45° field of view; 848x848.
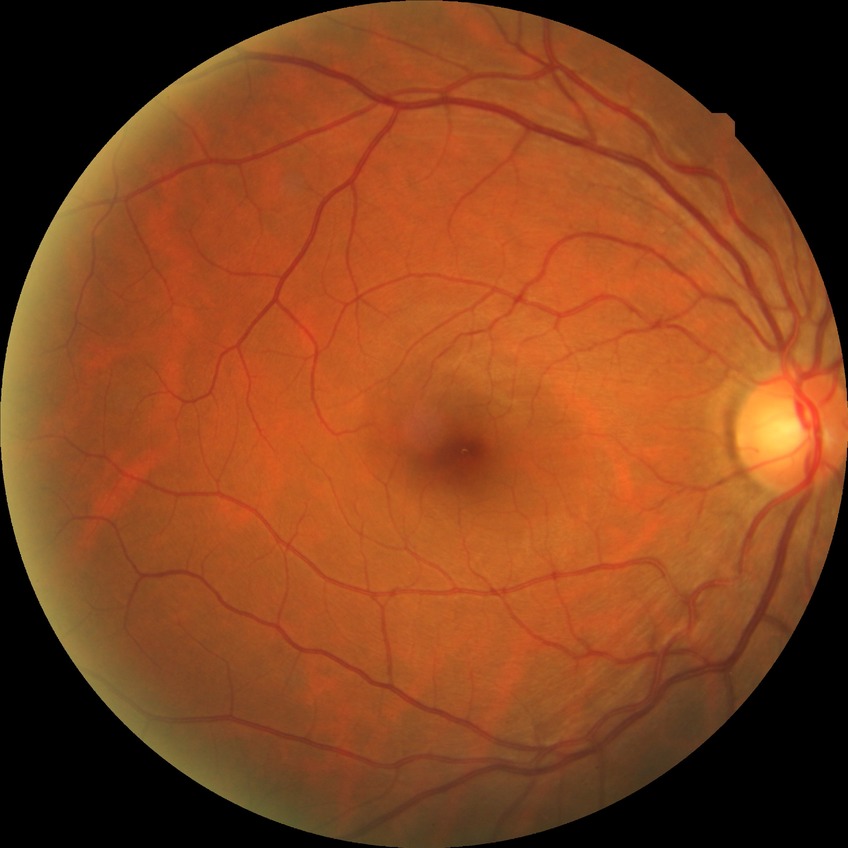

Diabetic retinopathy (DR) is NDR (no diabetic retinopathy).